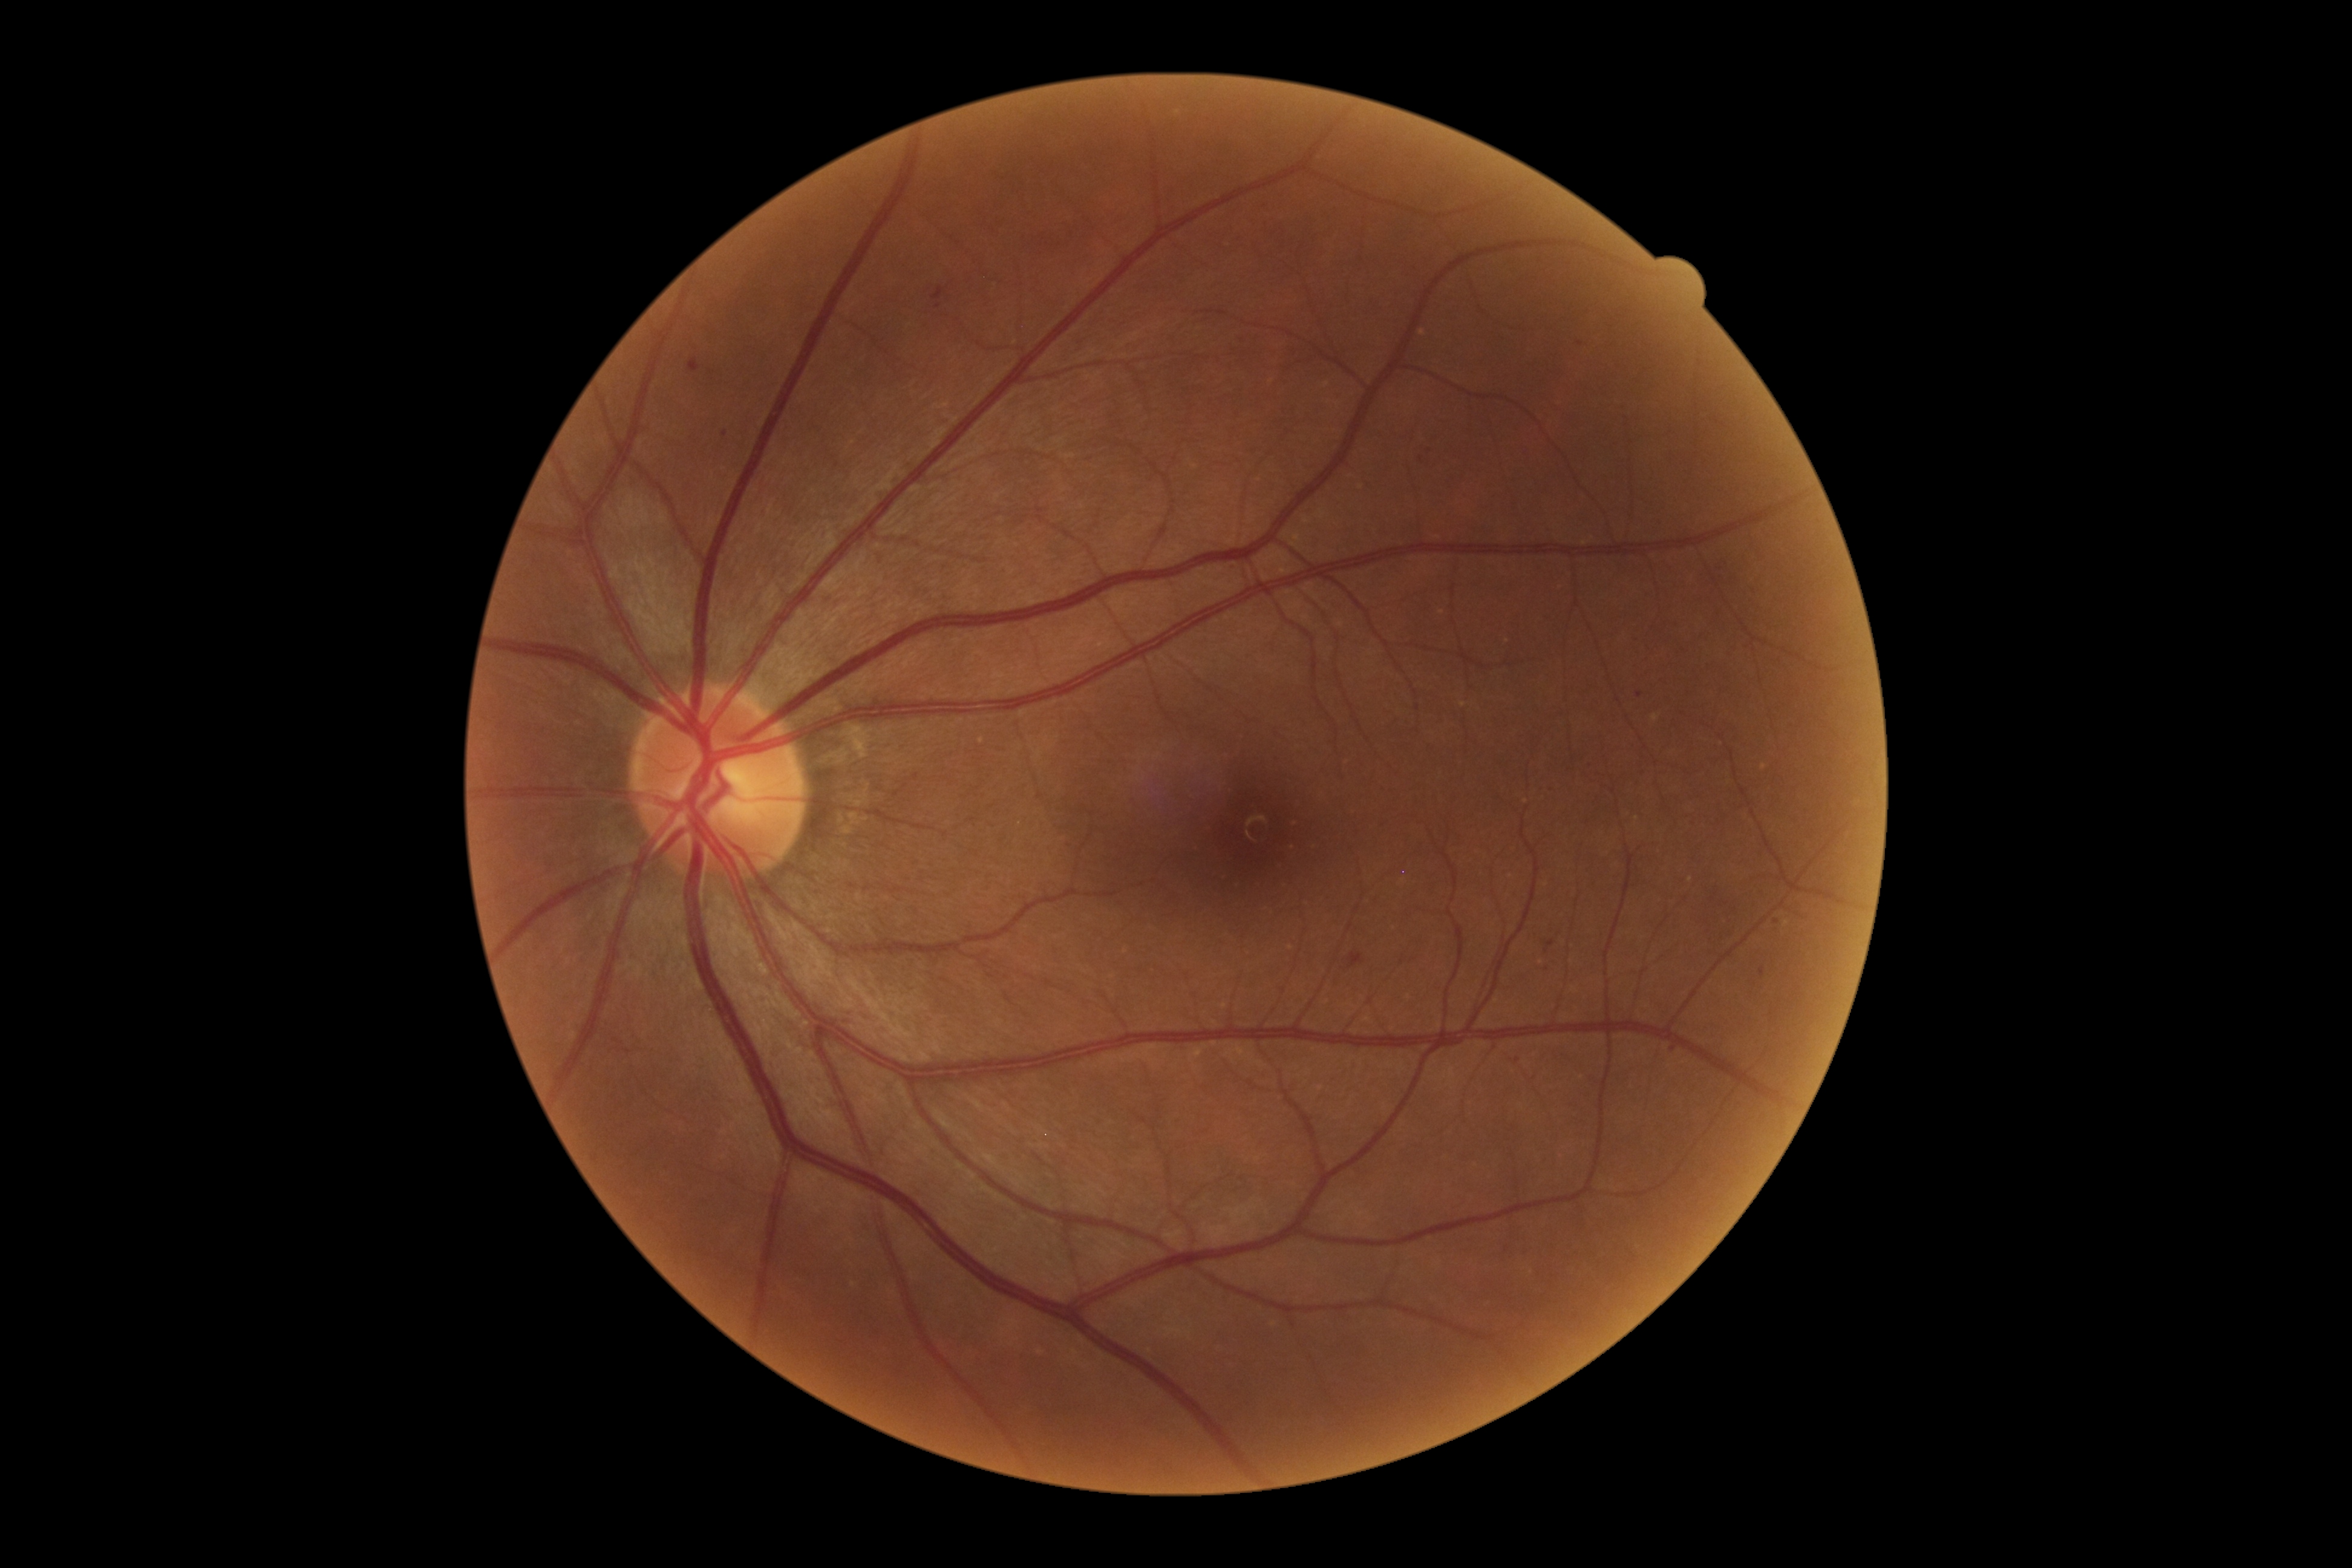 diabetic retinopathy (DR)=2/4.